FOV: 45 degrees; retinal fundus photograph
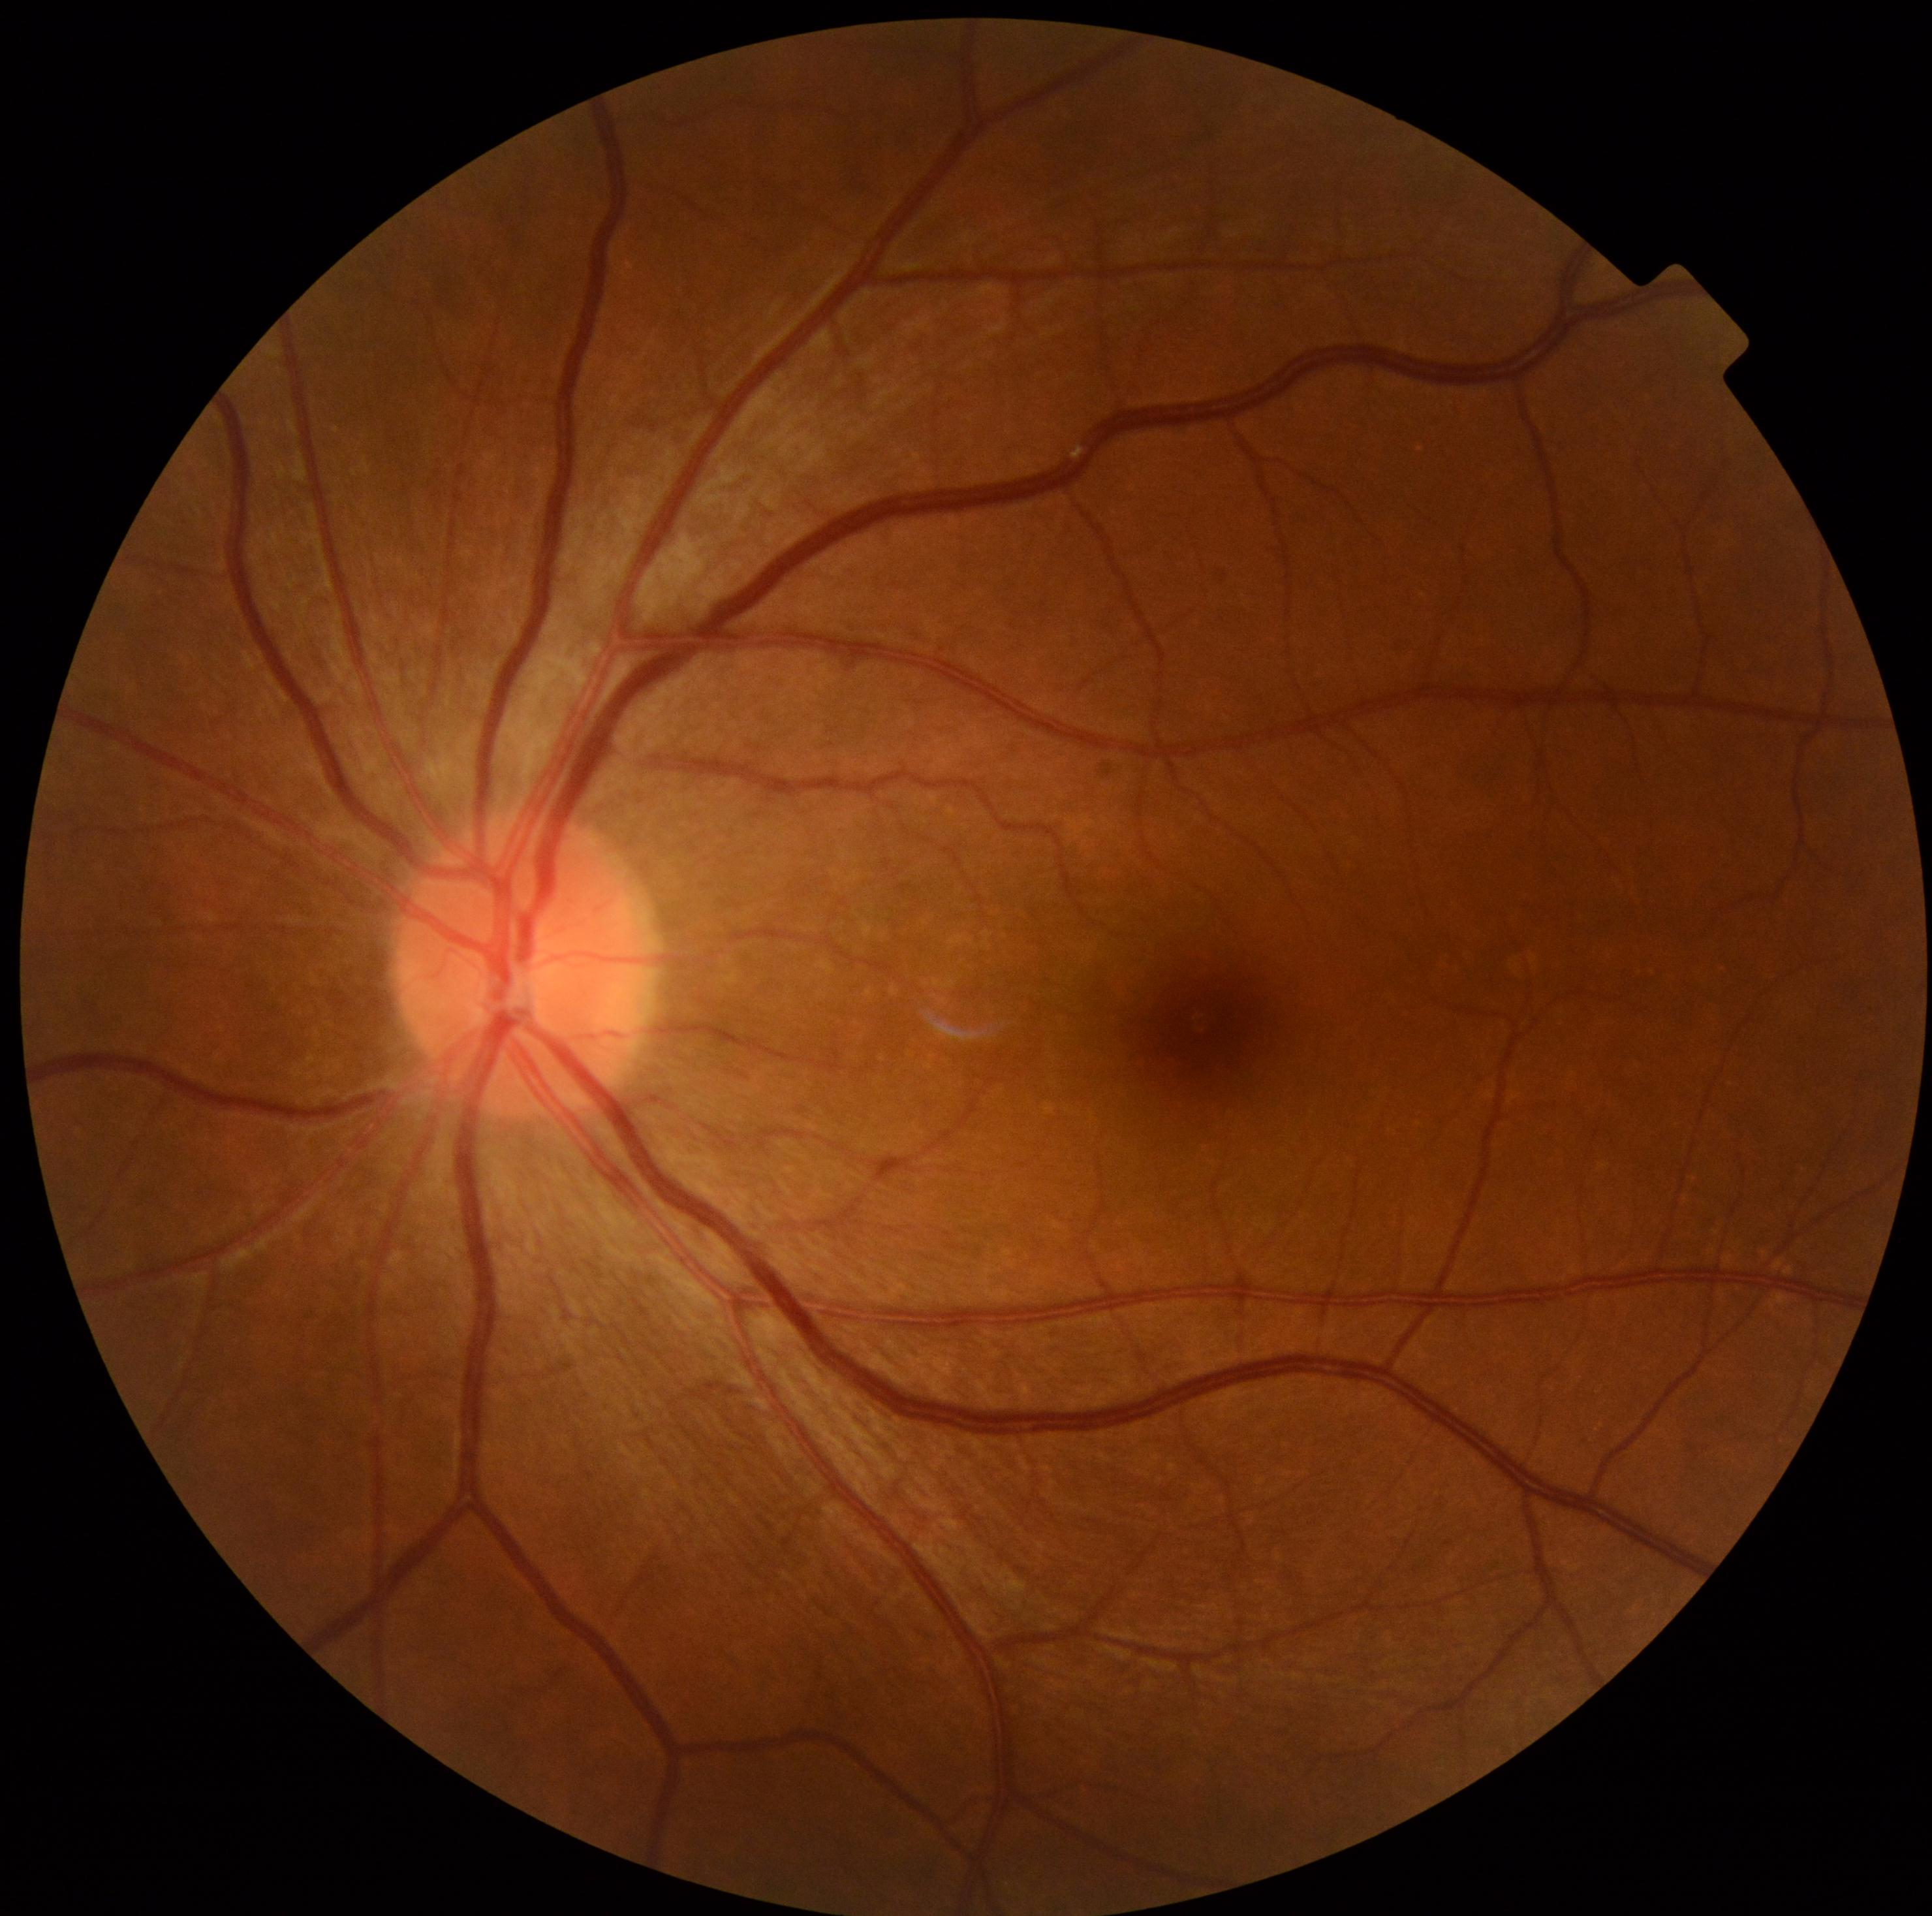
Findings:
- DR stage — no apparent retinopathy (grade 0)
- DR impression — no DR findings